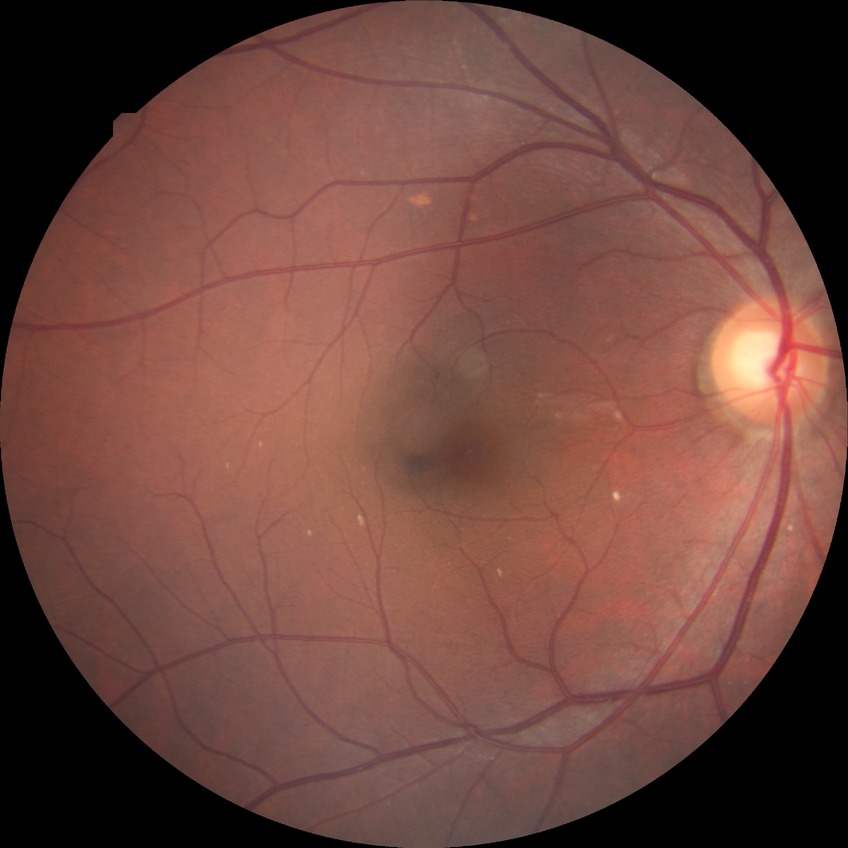
Retinopathy grade is no diabetic retinopathy.